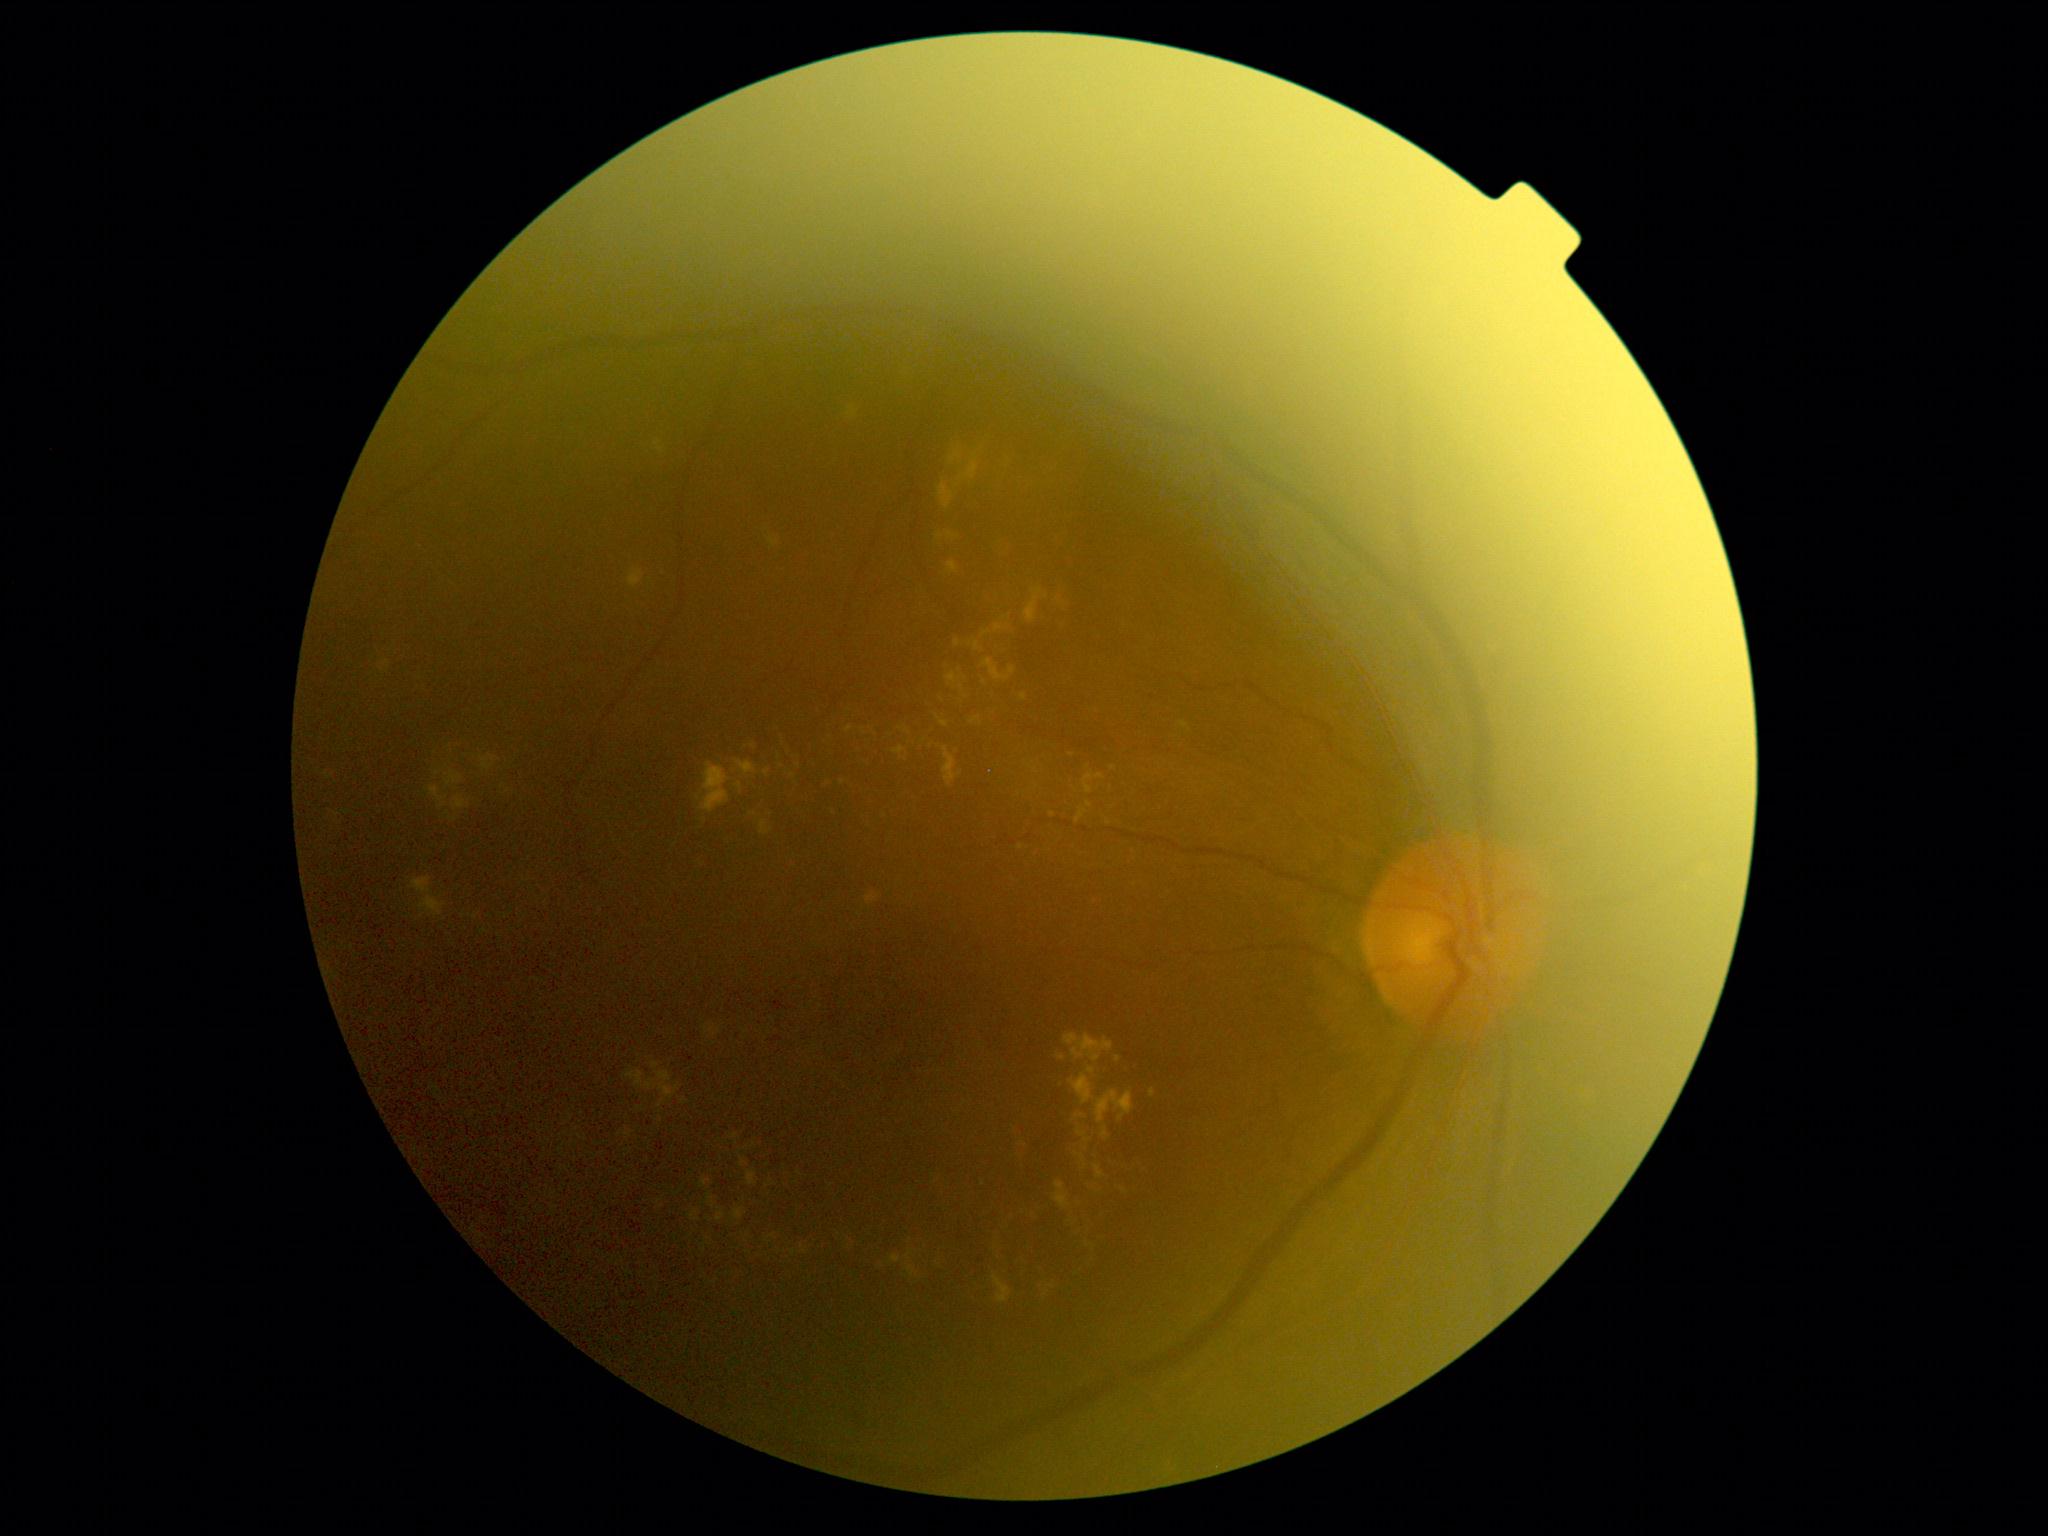
<lesions partial="true">
  <dr_grade>2</dr_grade>
  <he />
  <ex partial="true">654,439,664,454 | 1095,1091,1134,1124 | 946,673,962,686 | 625,1131,634,1138 | 628,568,644,588 | 690,1210,700,1221 | 740,1158,749,1168 | 982,658,1011,683 | 1054,1181,1071,1210 | 866,893,880,905 | 906,1250,913,1261 | 945,425,996,489</ex>
  <ex_small_centers>[849,729] | [842,783] | [684,1101] | [1077,1155] | [959,671] | [794,1253] | [1023,697] | [698,798]</ex_small_centers>
  <se />
  <ma />
</lesions>